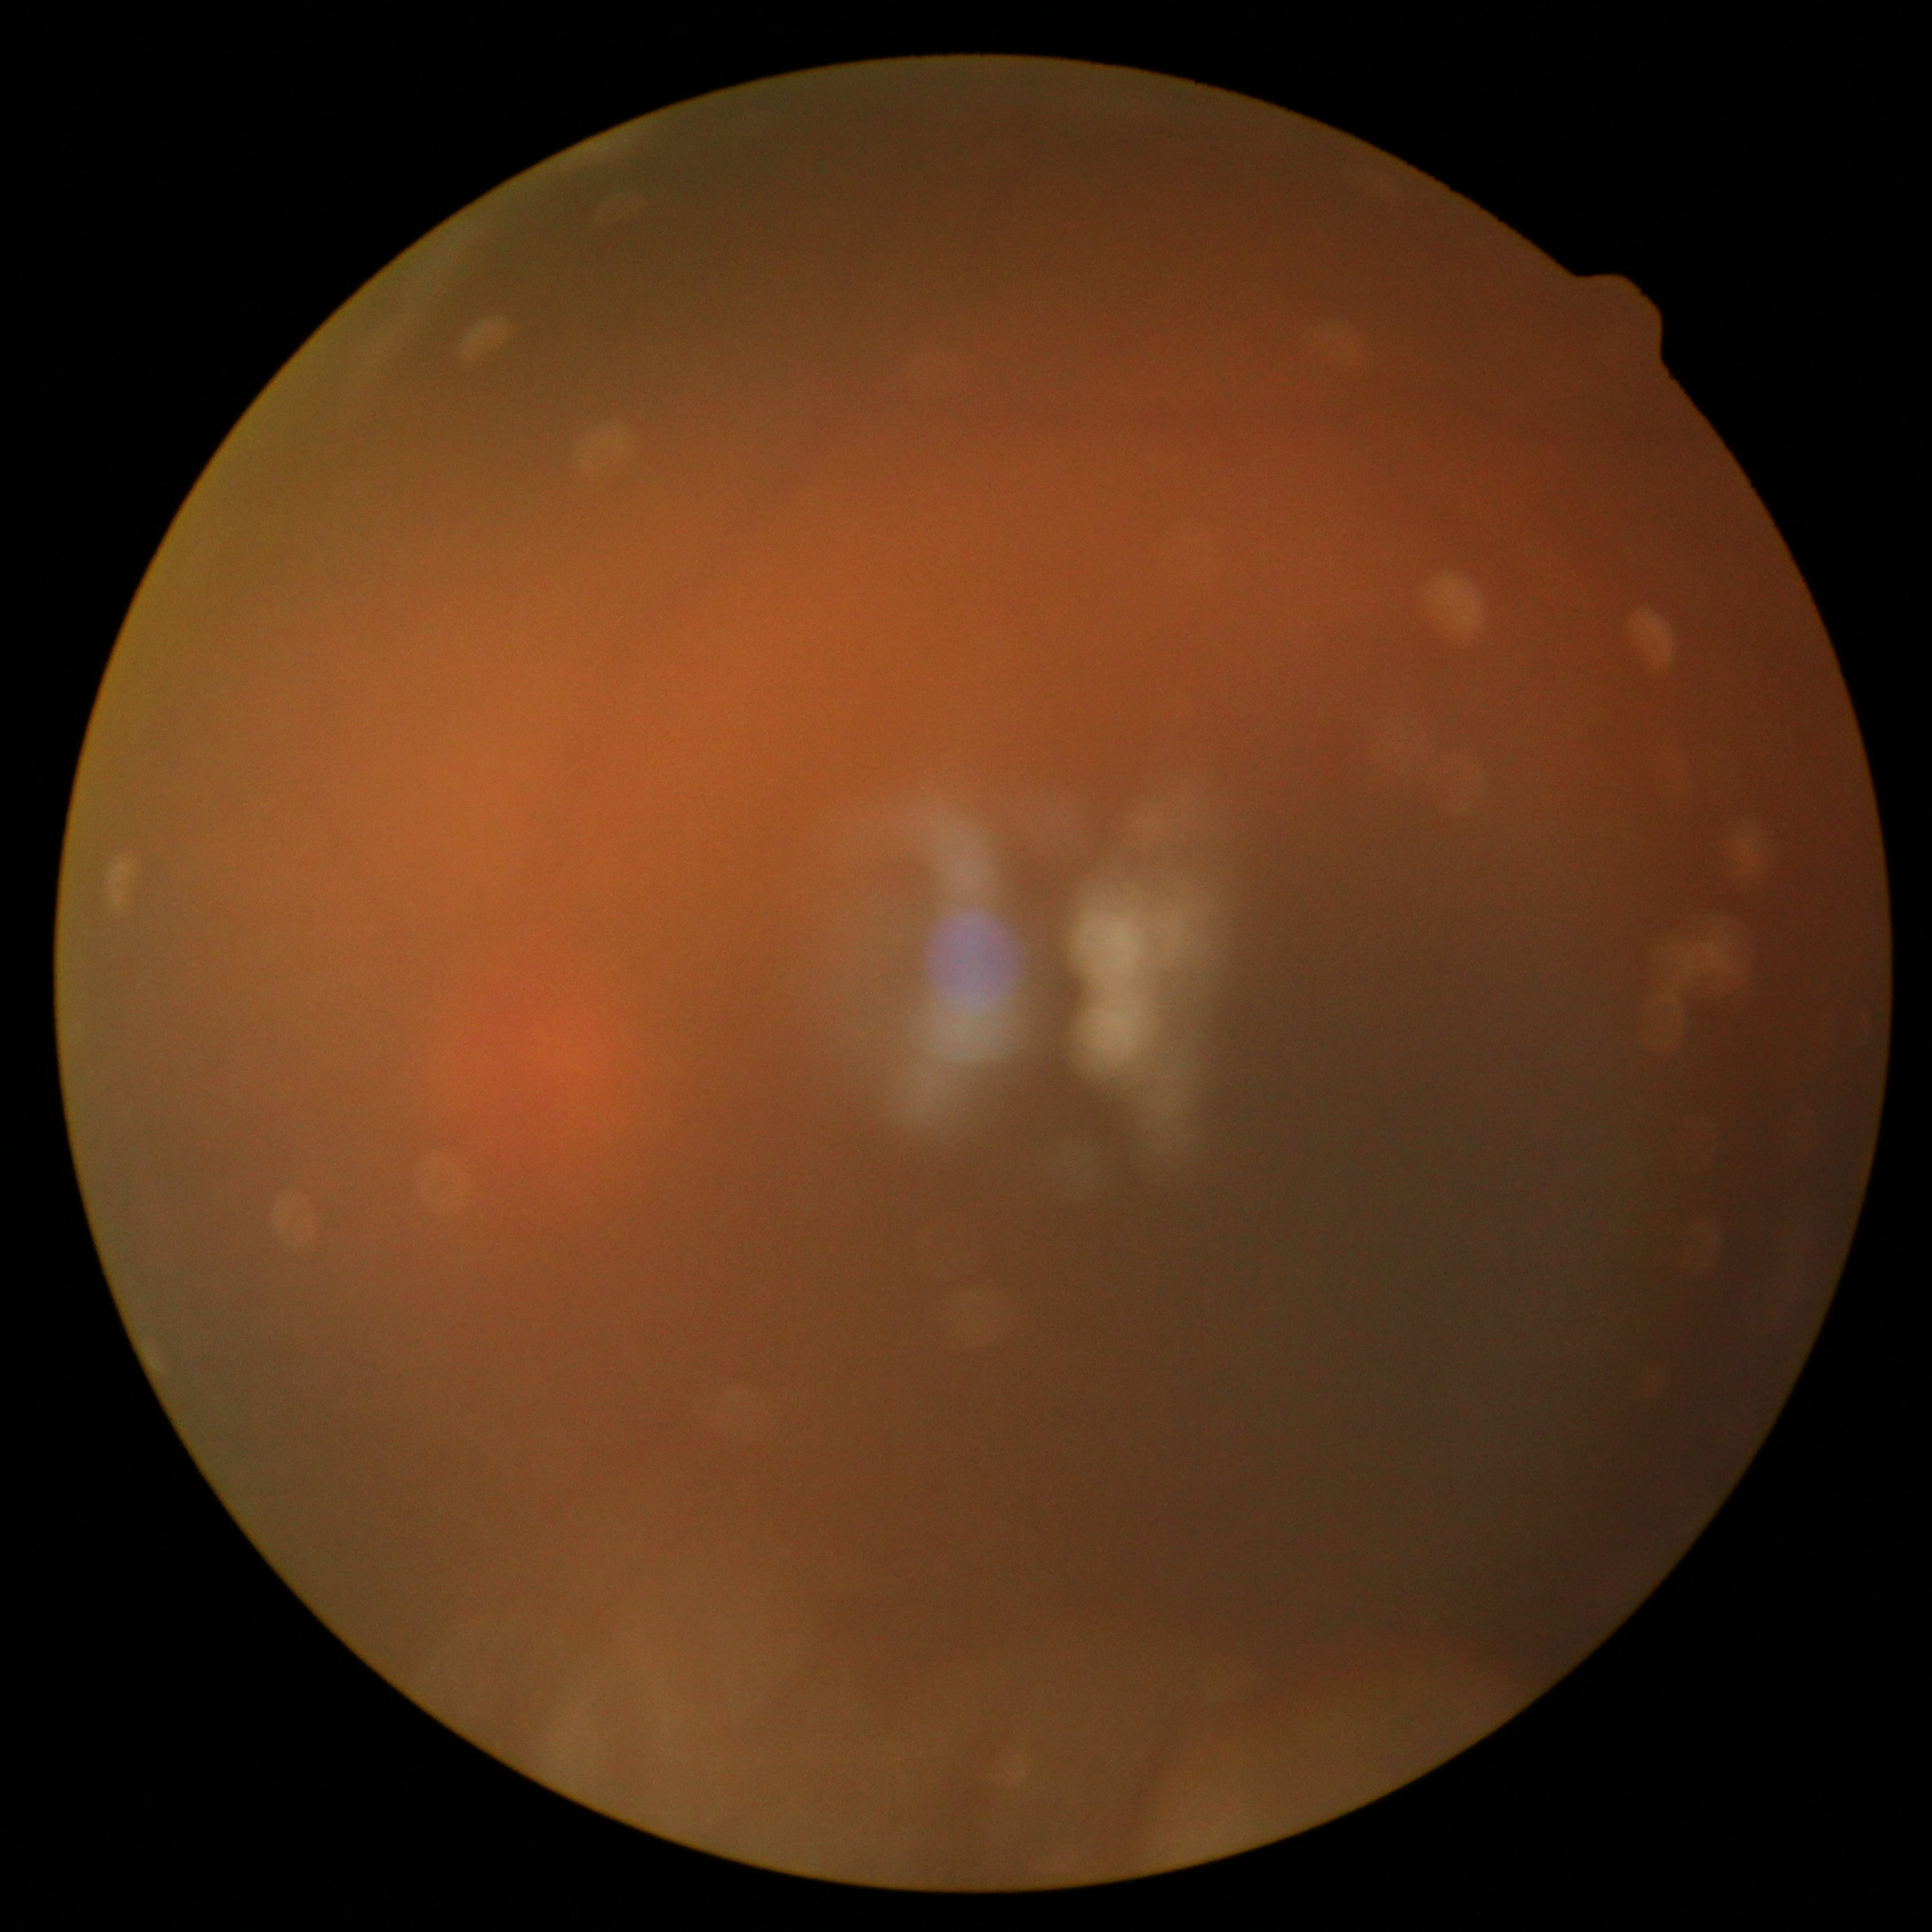

image quality=insufficient for DR assessment, diabetic retinopathy (DR)=ungradable due to poor image quality.